Ultra-widefield fundus mosaic: 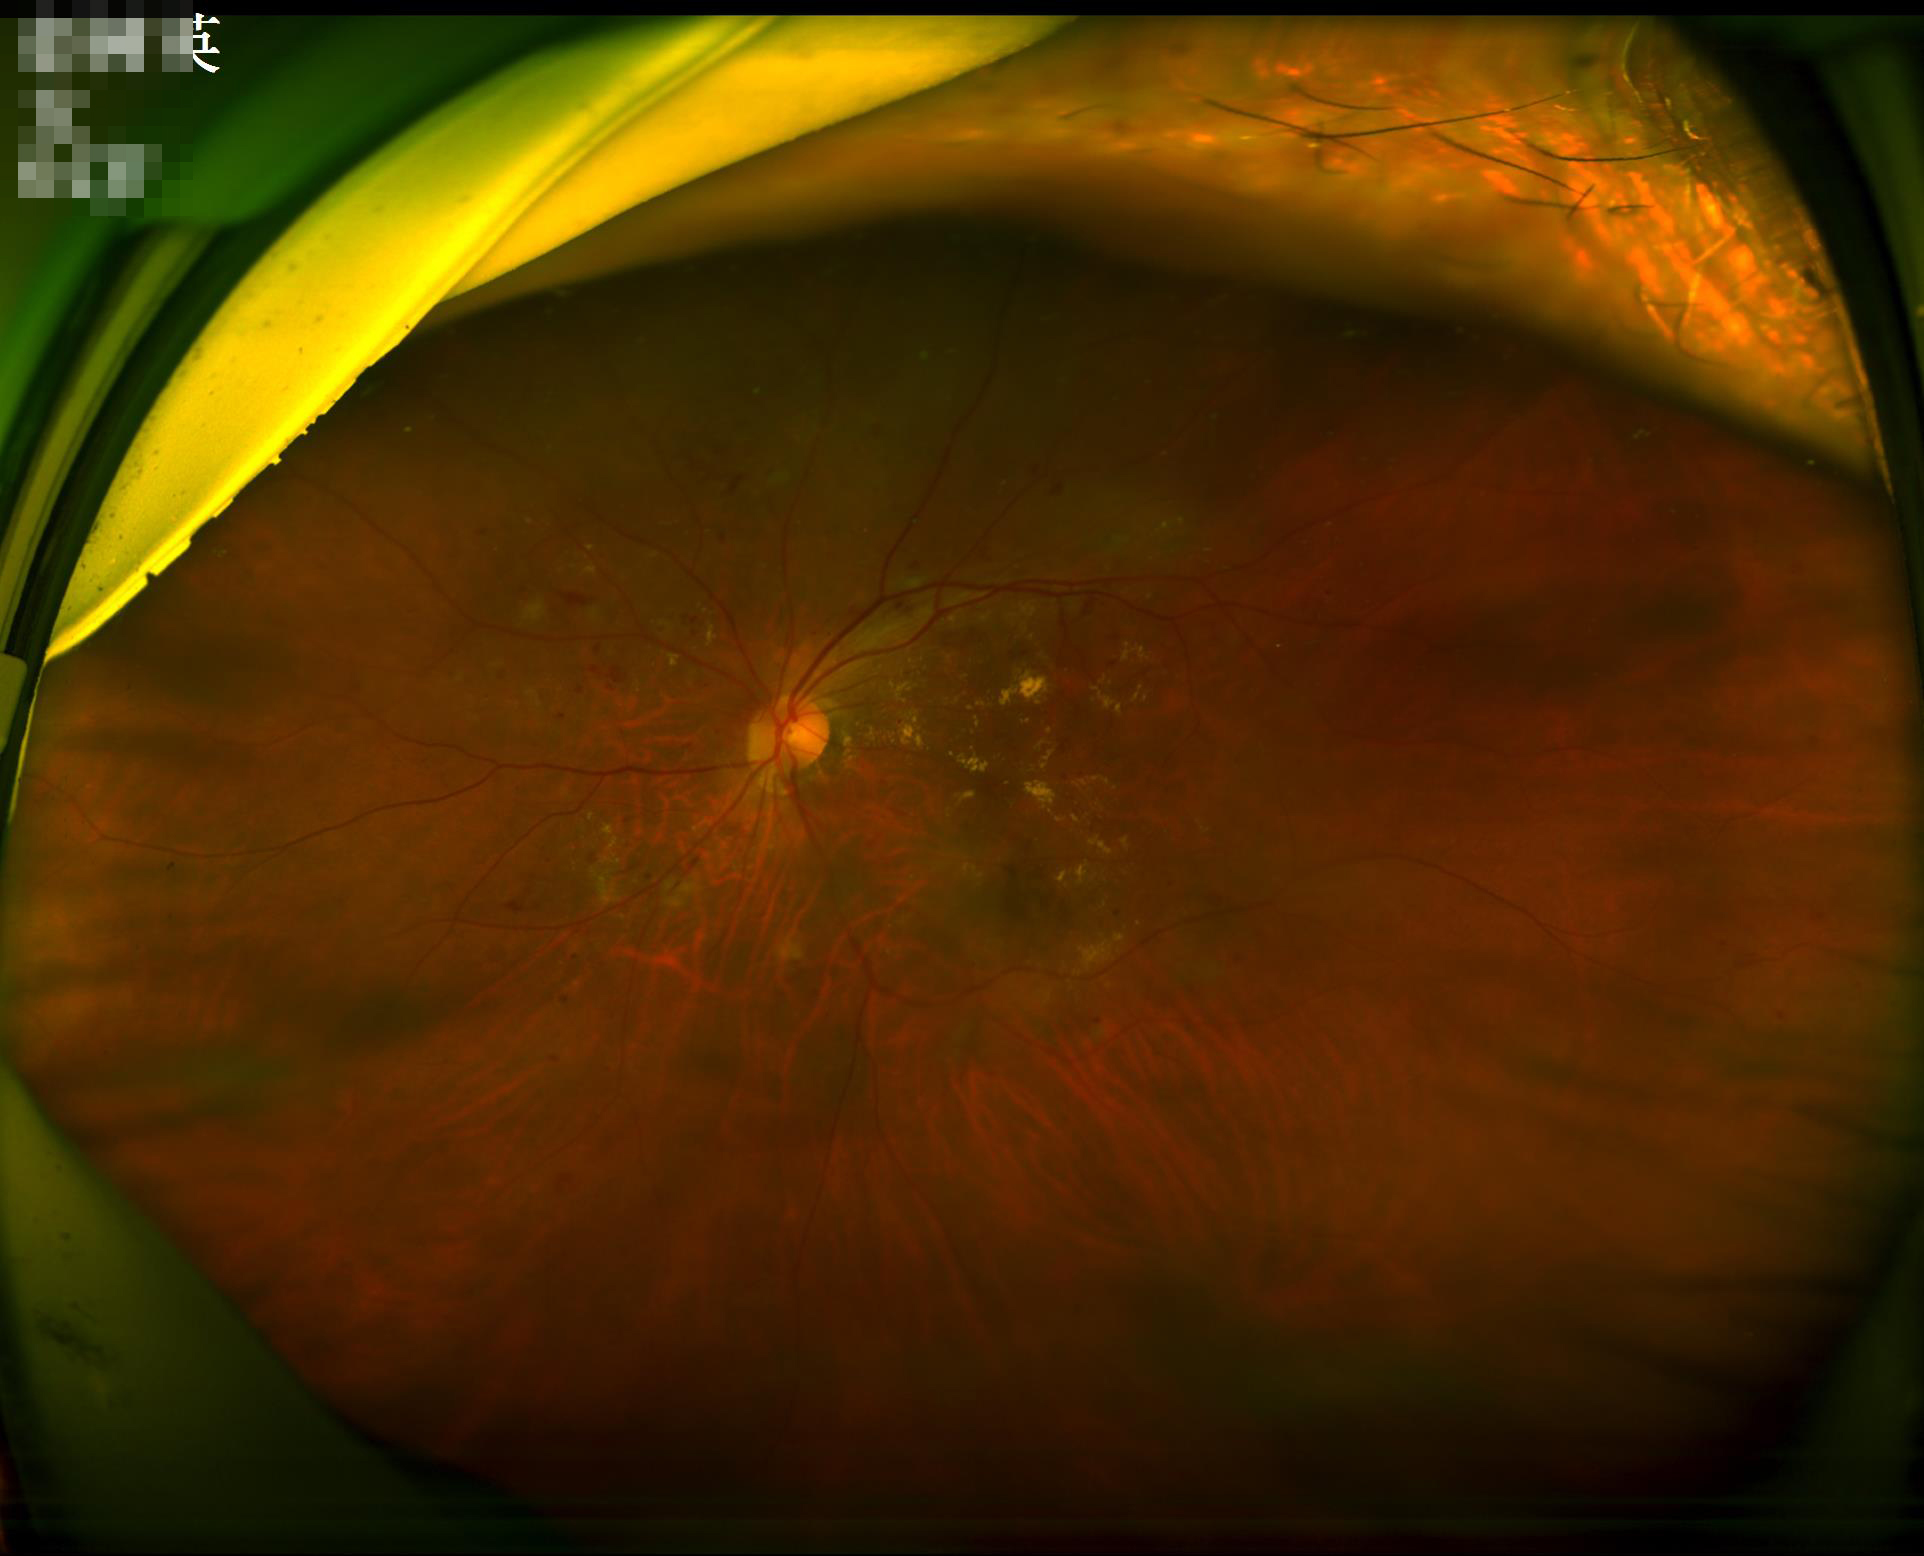

Clarity: out of focus, structures indistinct
Overall quality: inadequate for clinical interpretation
Illumination: over- or under-exposed